Fundus photo:
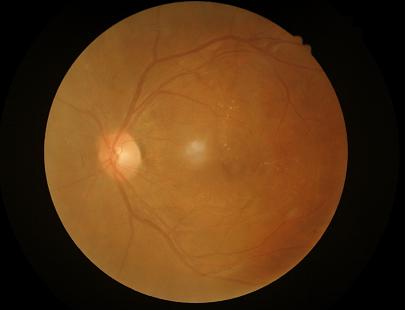
Quality grading: illumination/color: satisfactory | overall: inadequate | contrast: good | sharpness: out of focus.